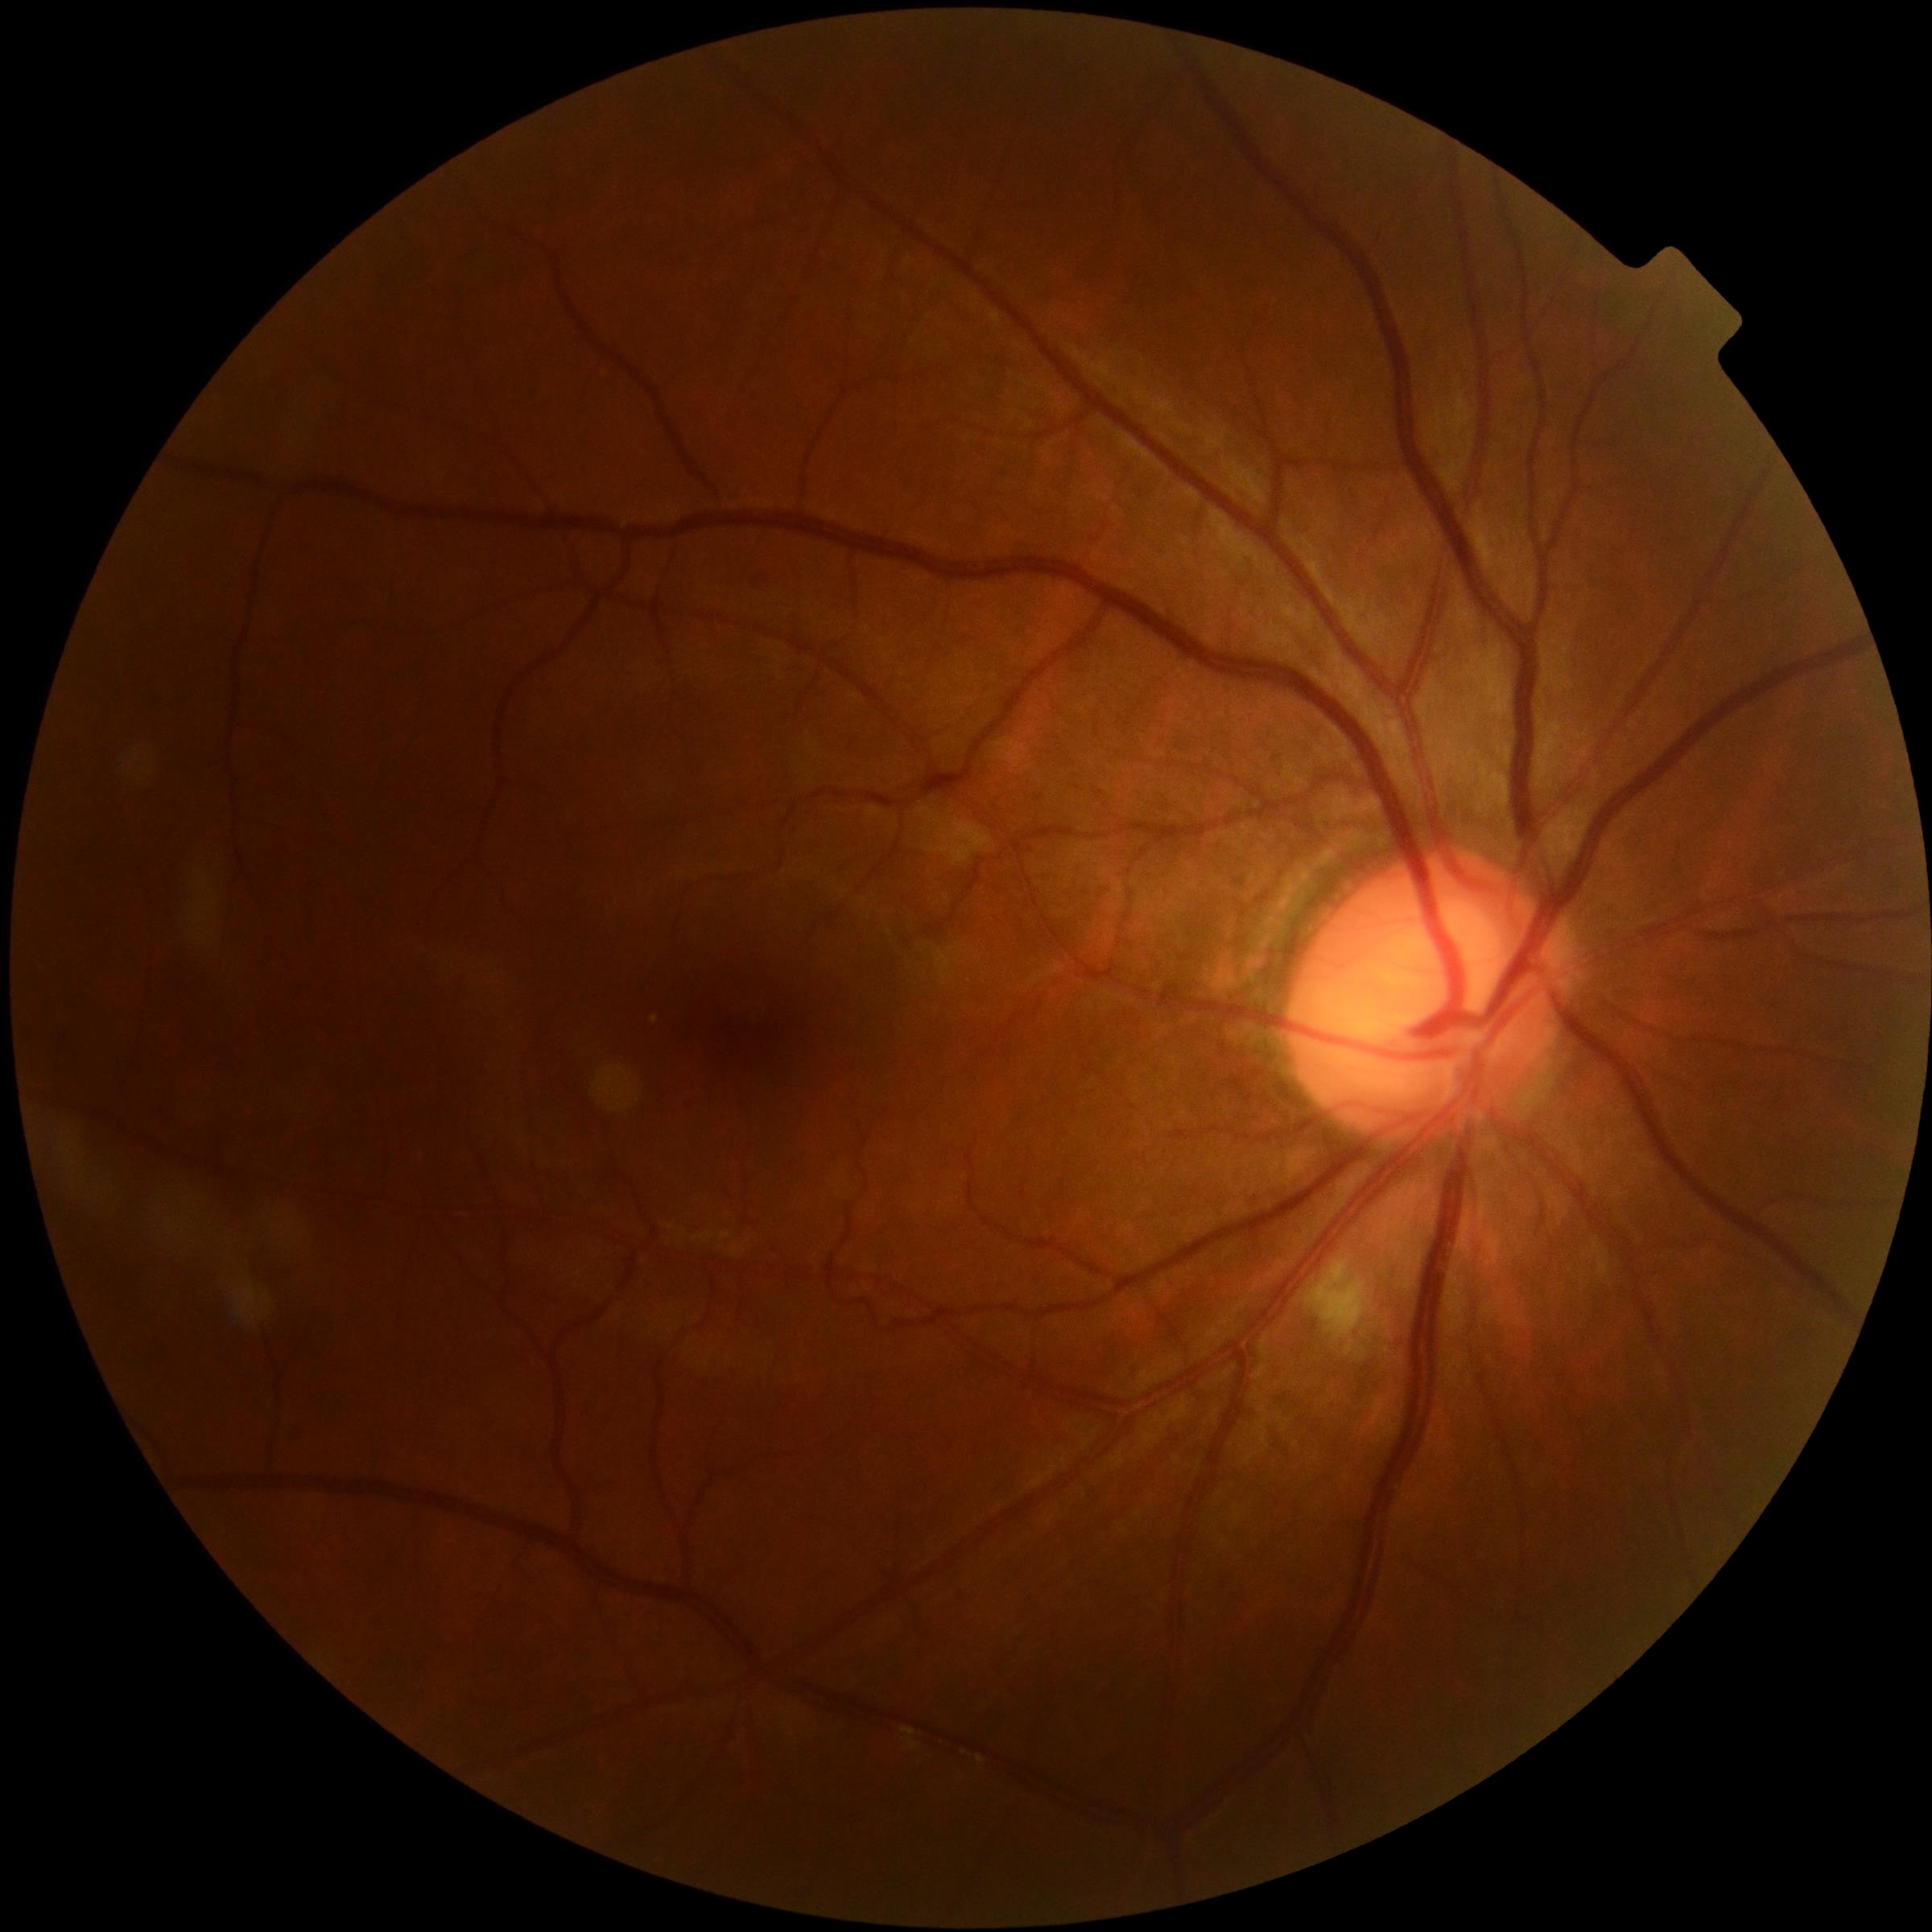
Retinopathy grade: 2/4 — more than just microaneurysms but less than severe NPDR.